848x848.
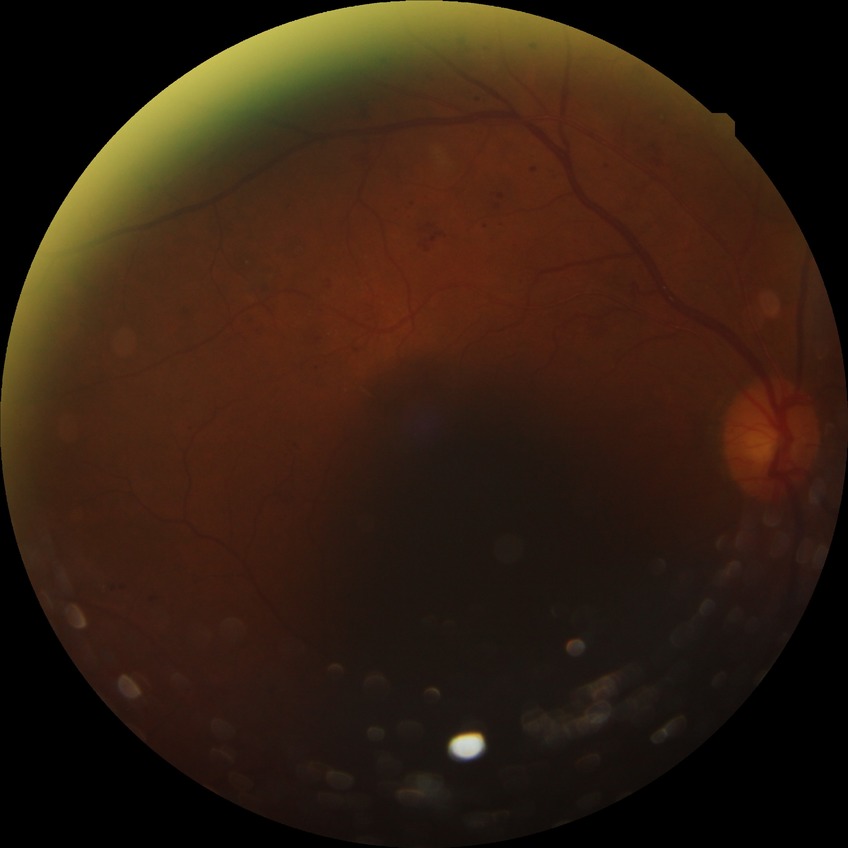

Retinopathy stage is proliferative diabetic retinopathy.